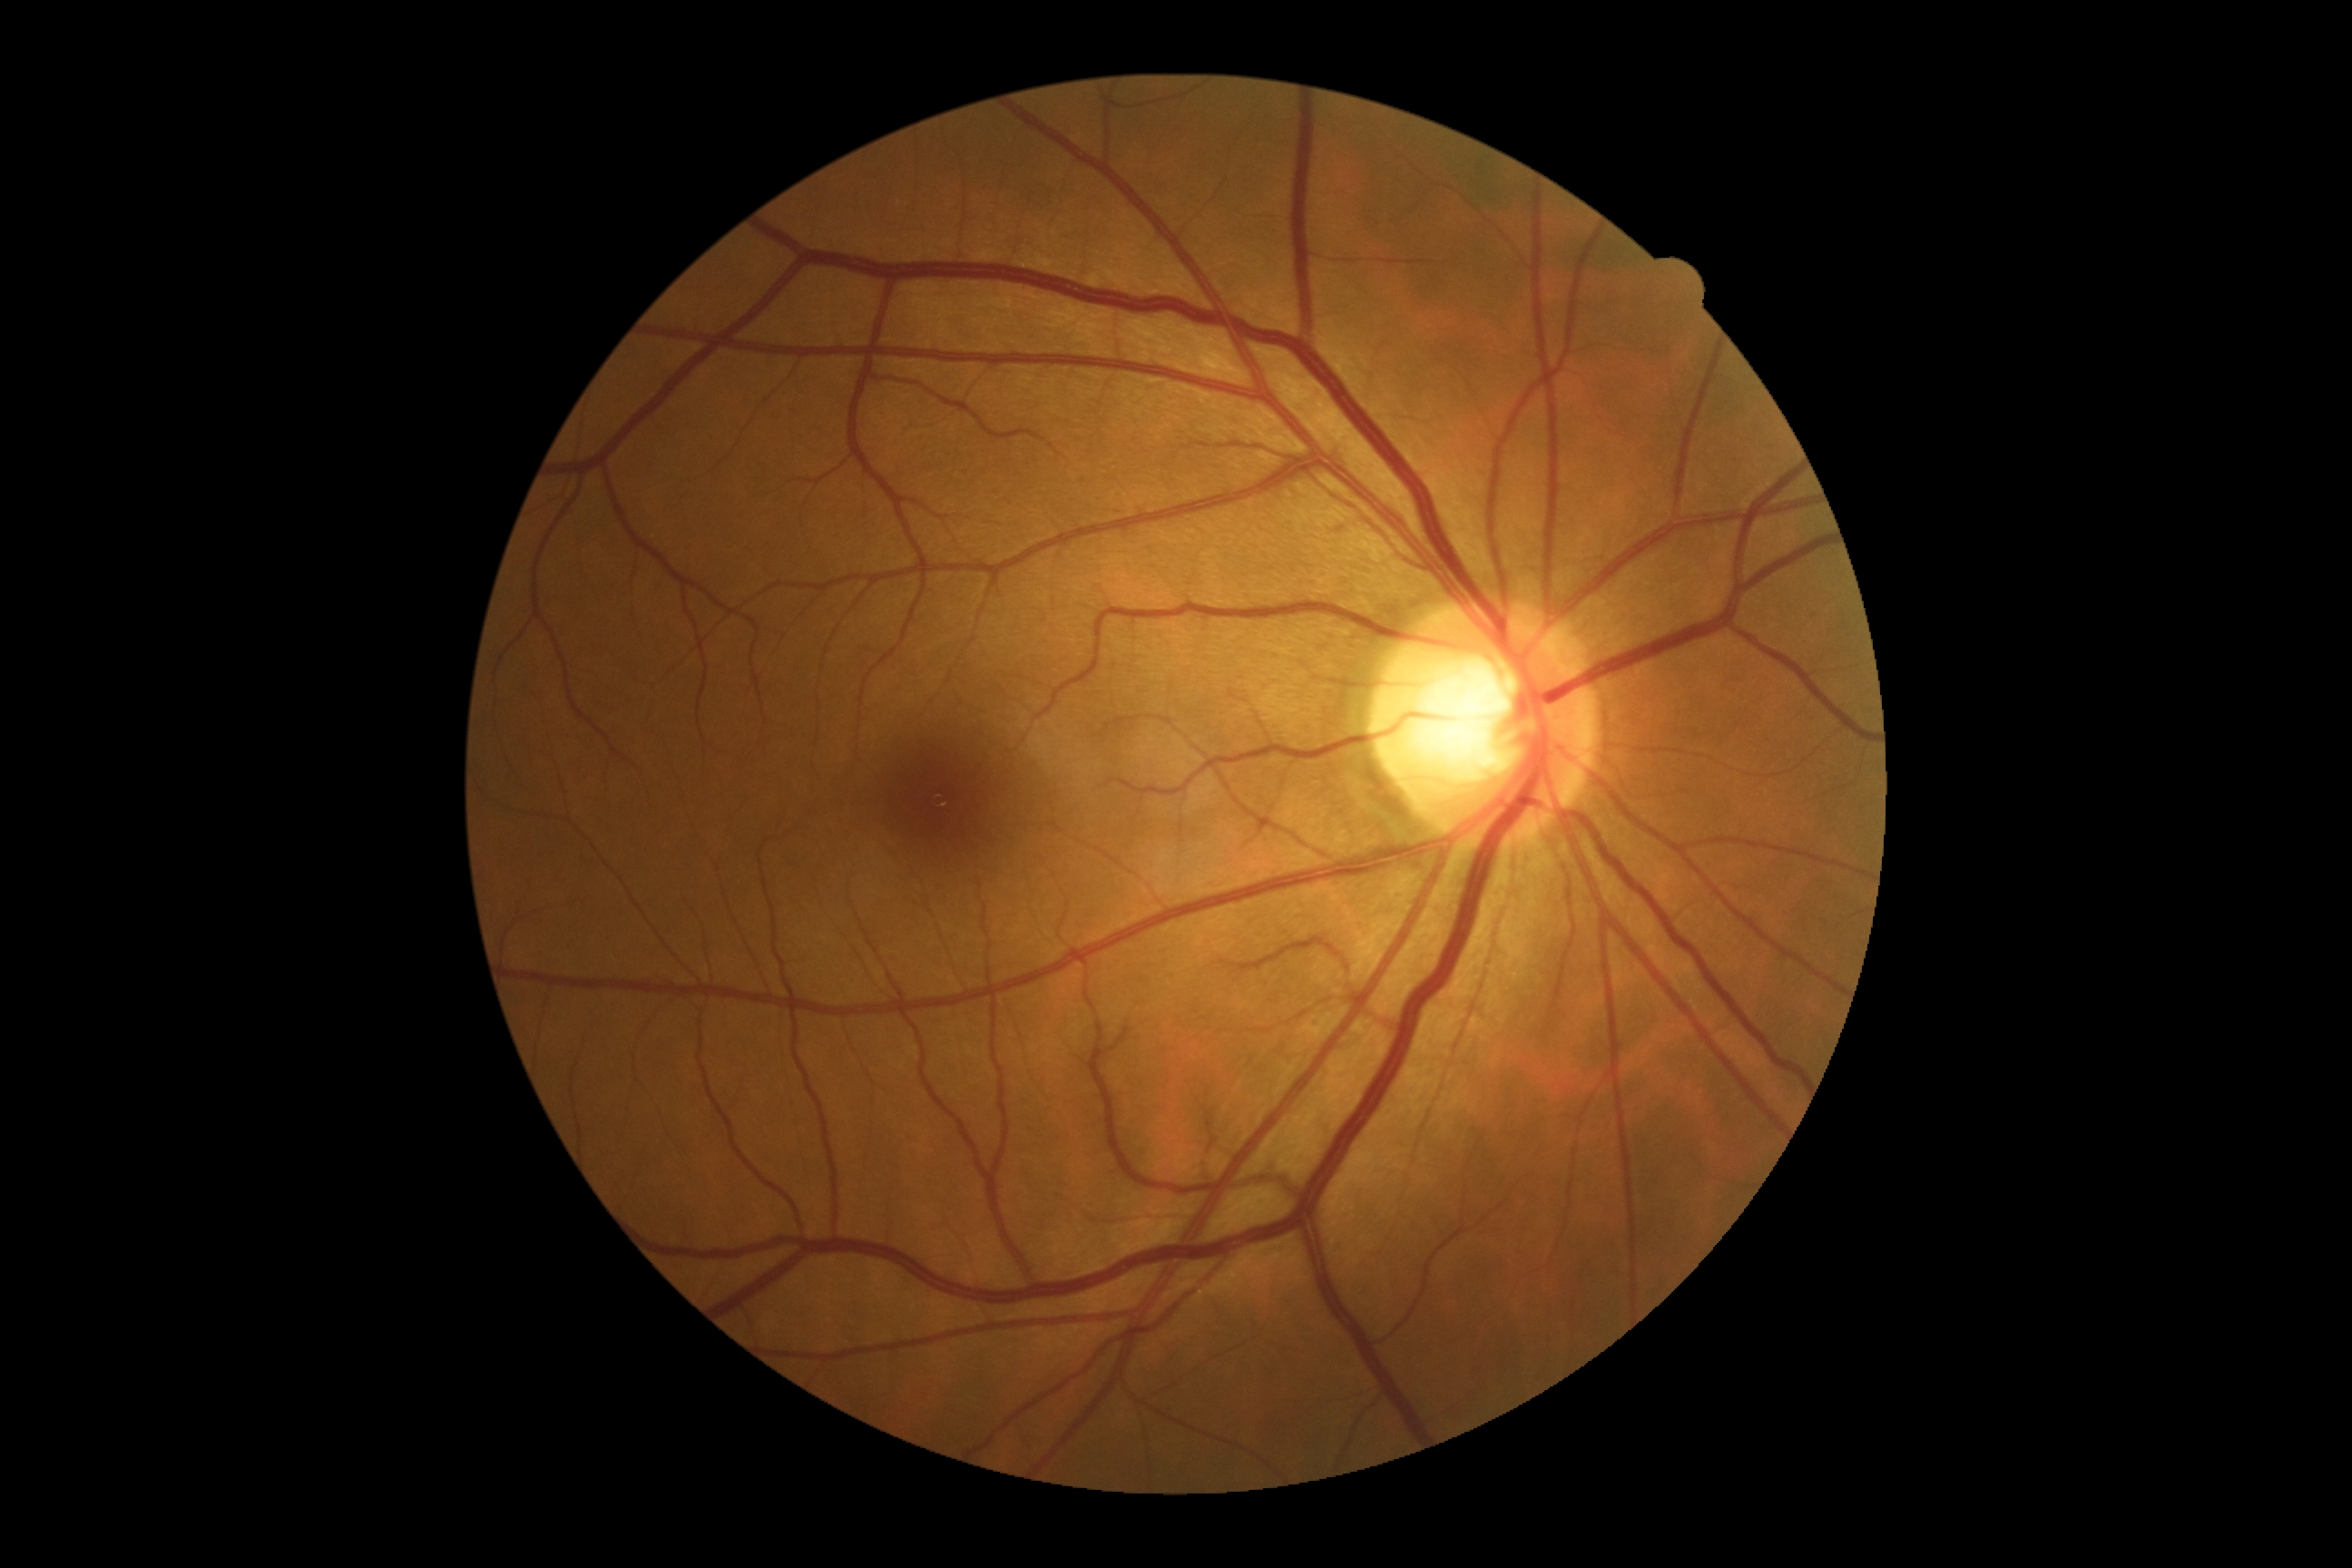
diabetic retinopathy (DR)@0 — no visible signs of diabetic retinopathy; DR impression@no DR findings.